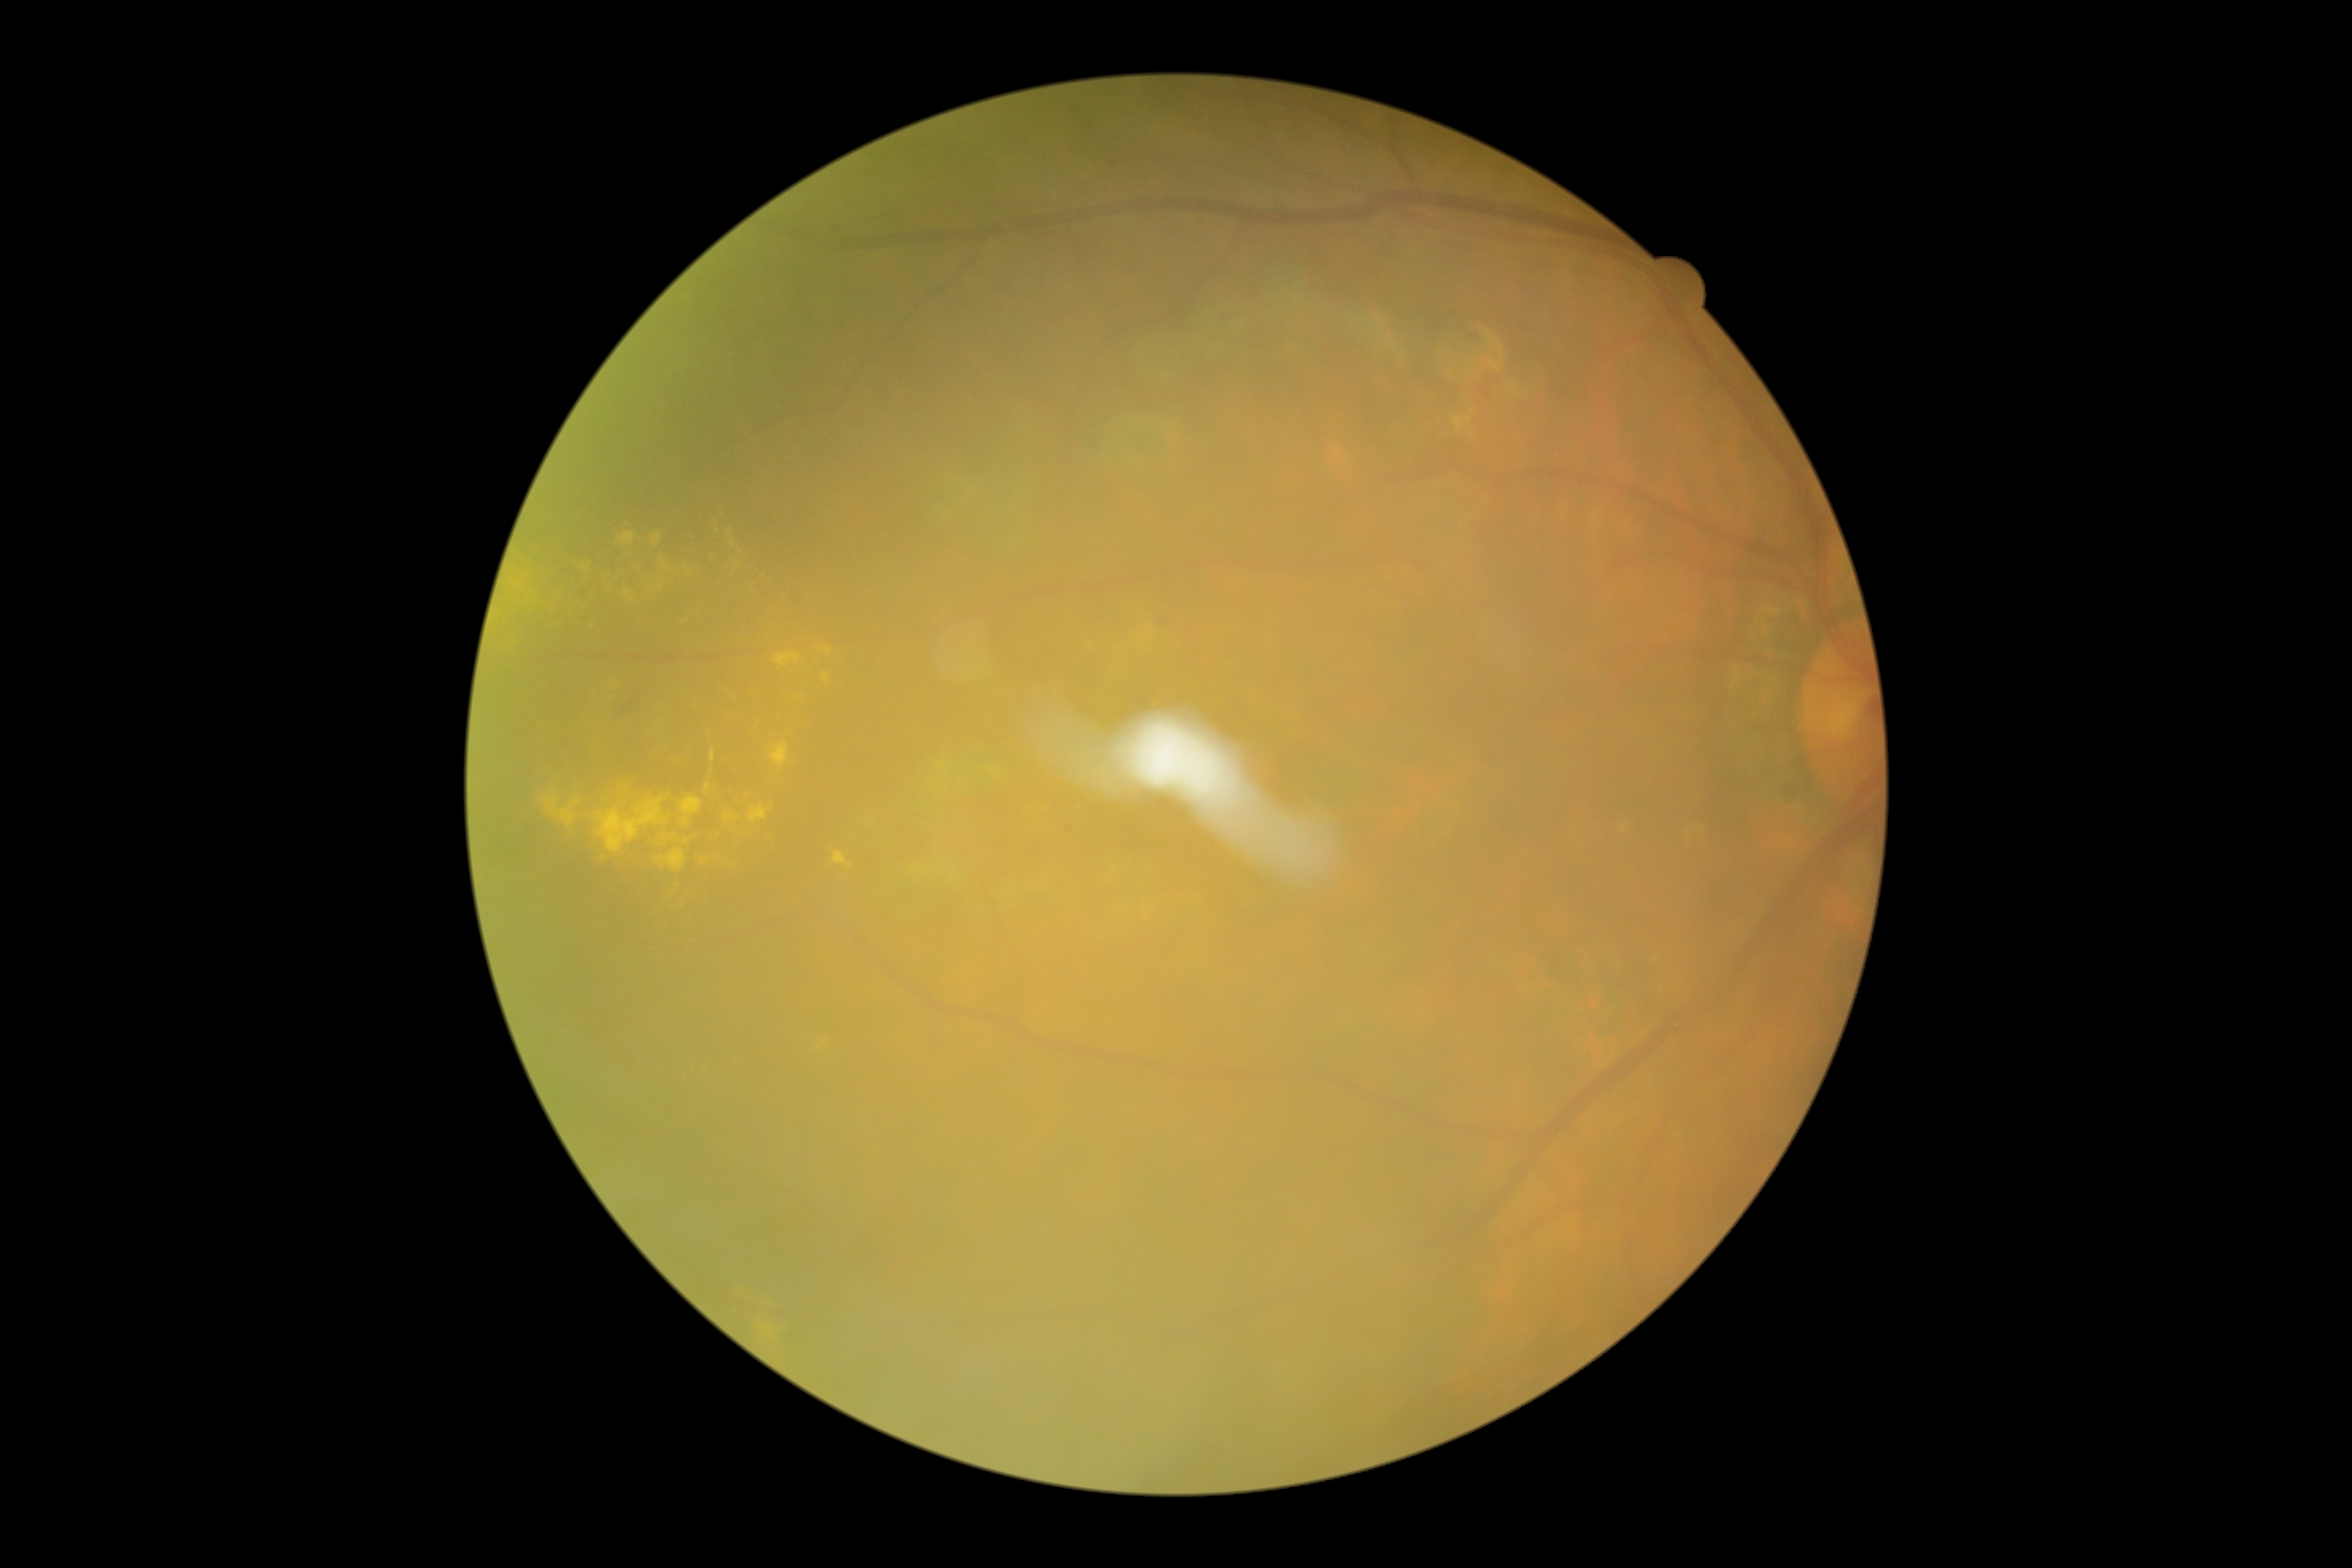 dr_grade: 2